Color fundus photograph, 2089x1764
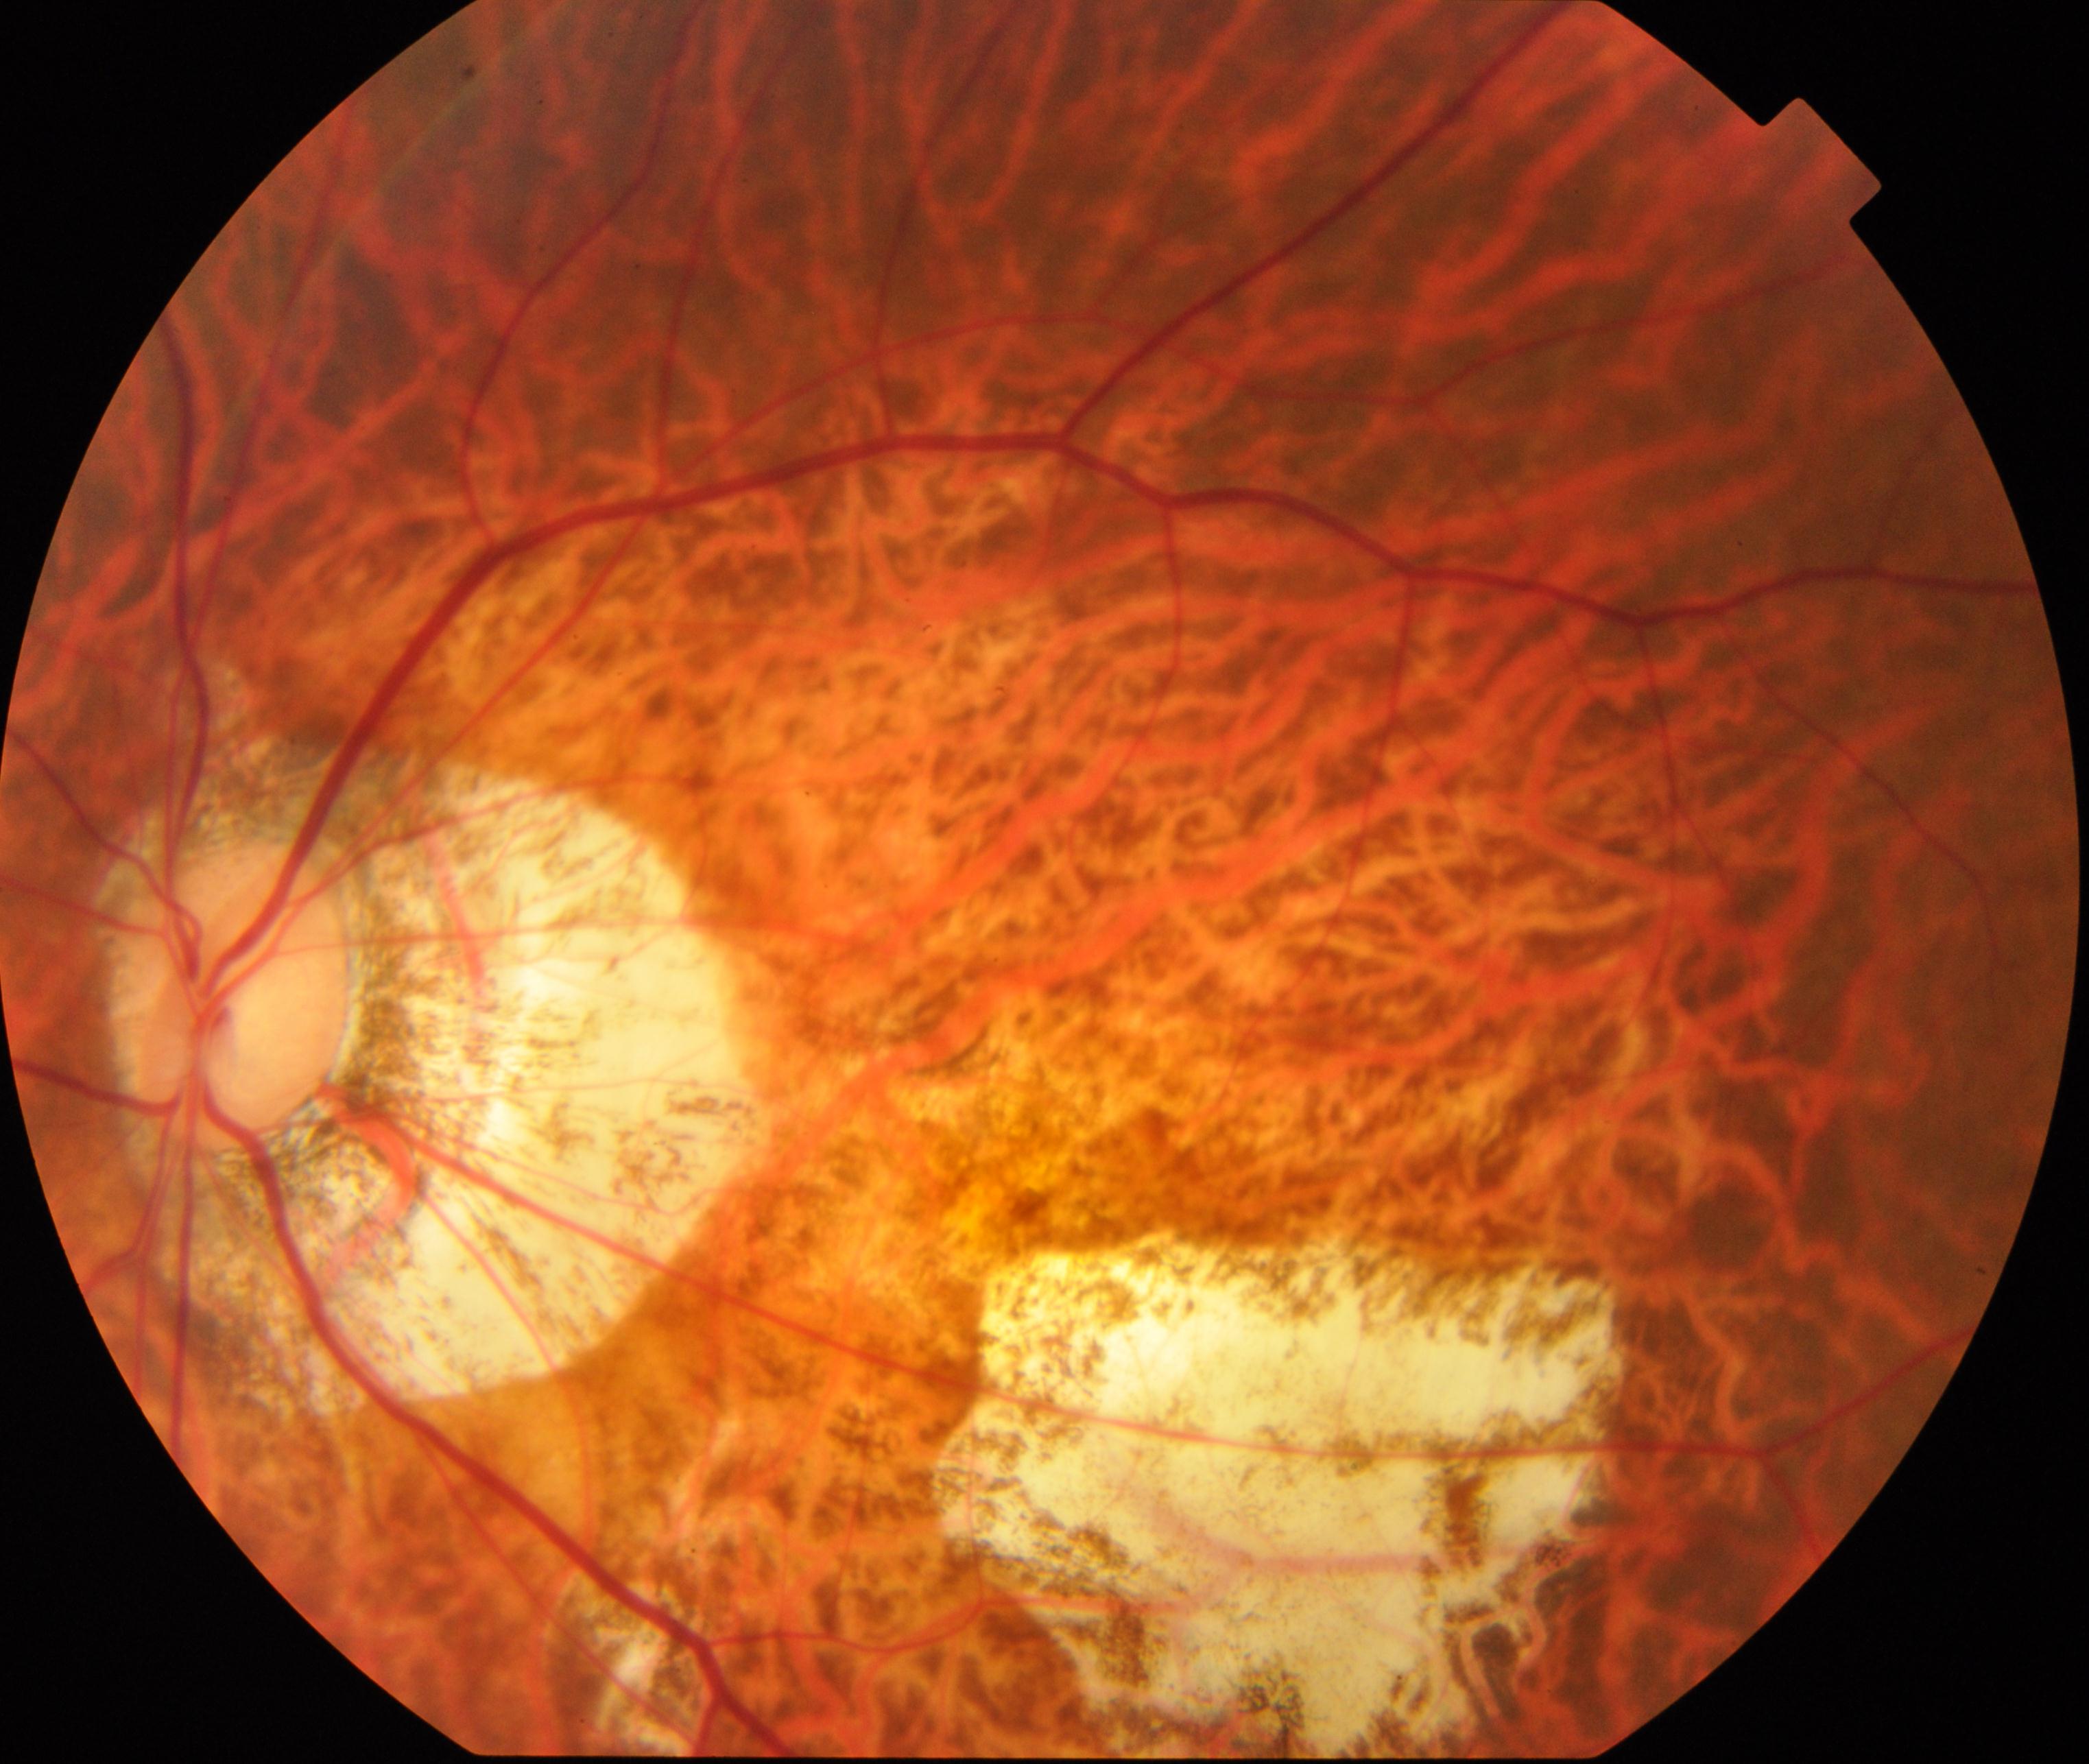

Demonstrates pathological myopia. Defined by tessellated fundus with focal chorioretinal atrophy, Fuchs spot, lacquer cracks, choroidal neovascularization, or subretinal hemorrhage.